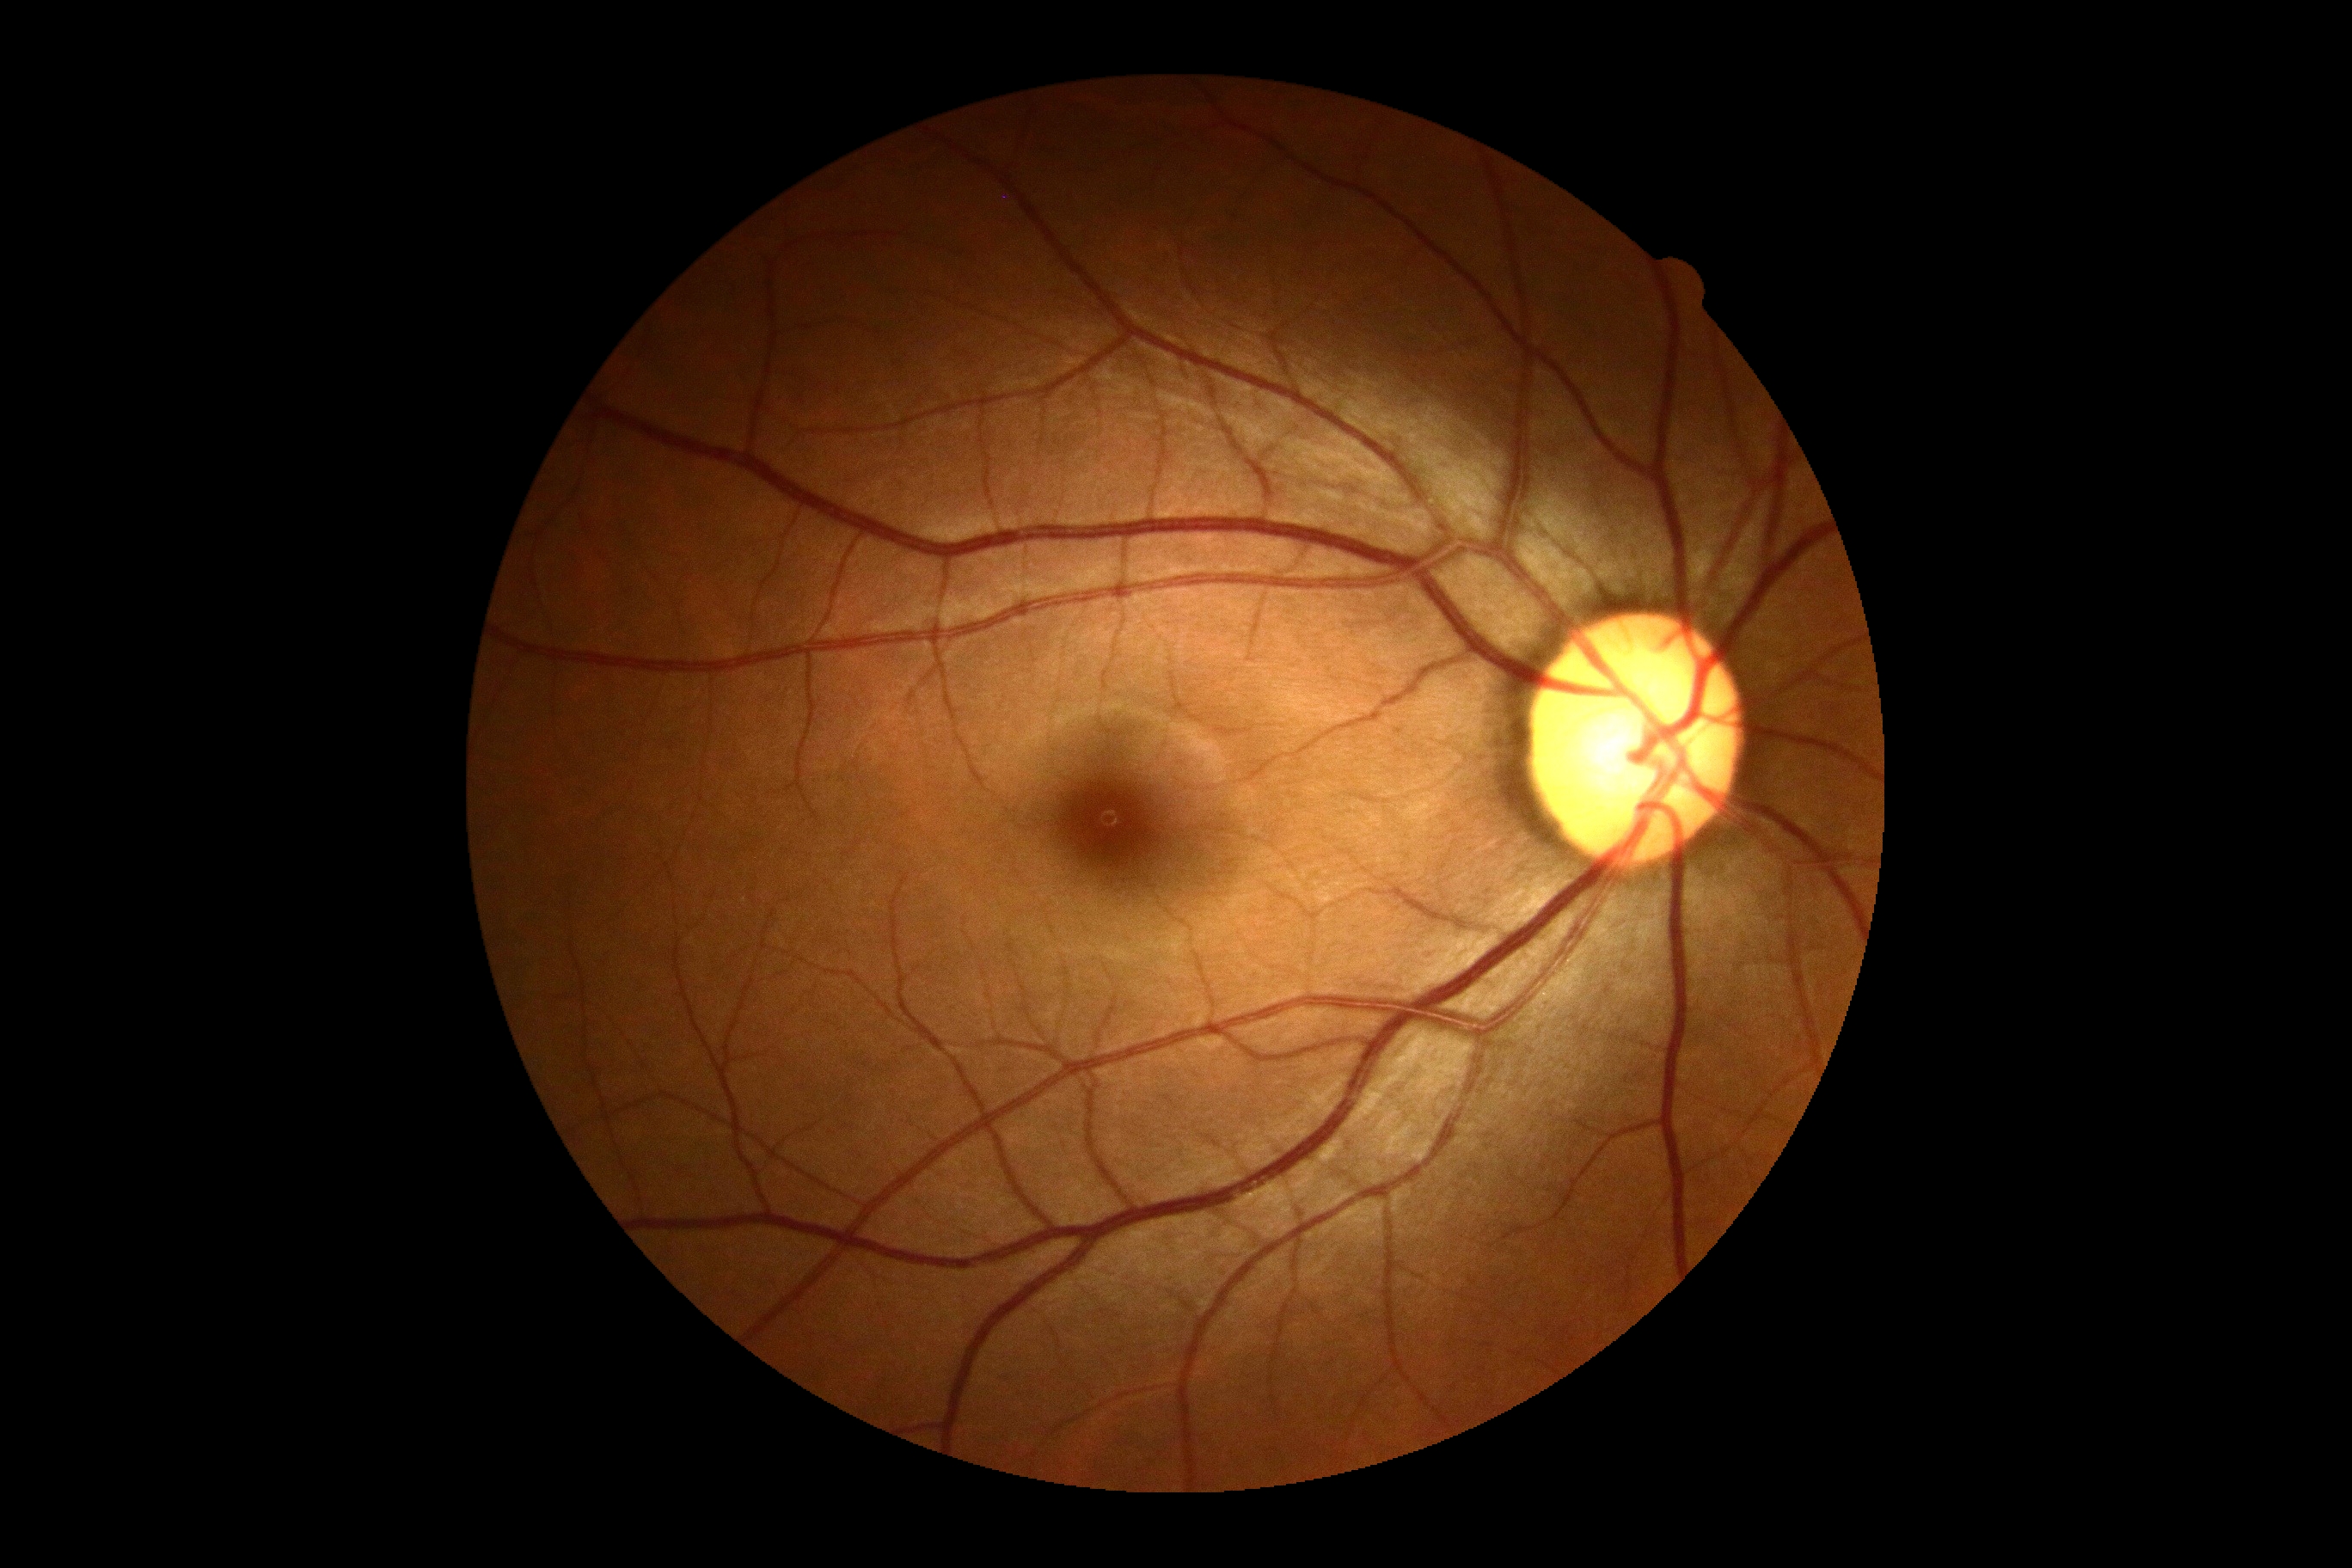
Findings:
* diabetic retinopathy (DR): 0 — no visible signs of diabetic retinopathy